1932x1910, 45° field of view, color fundus image
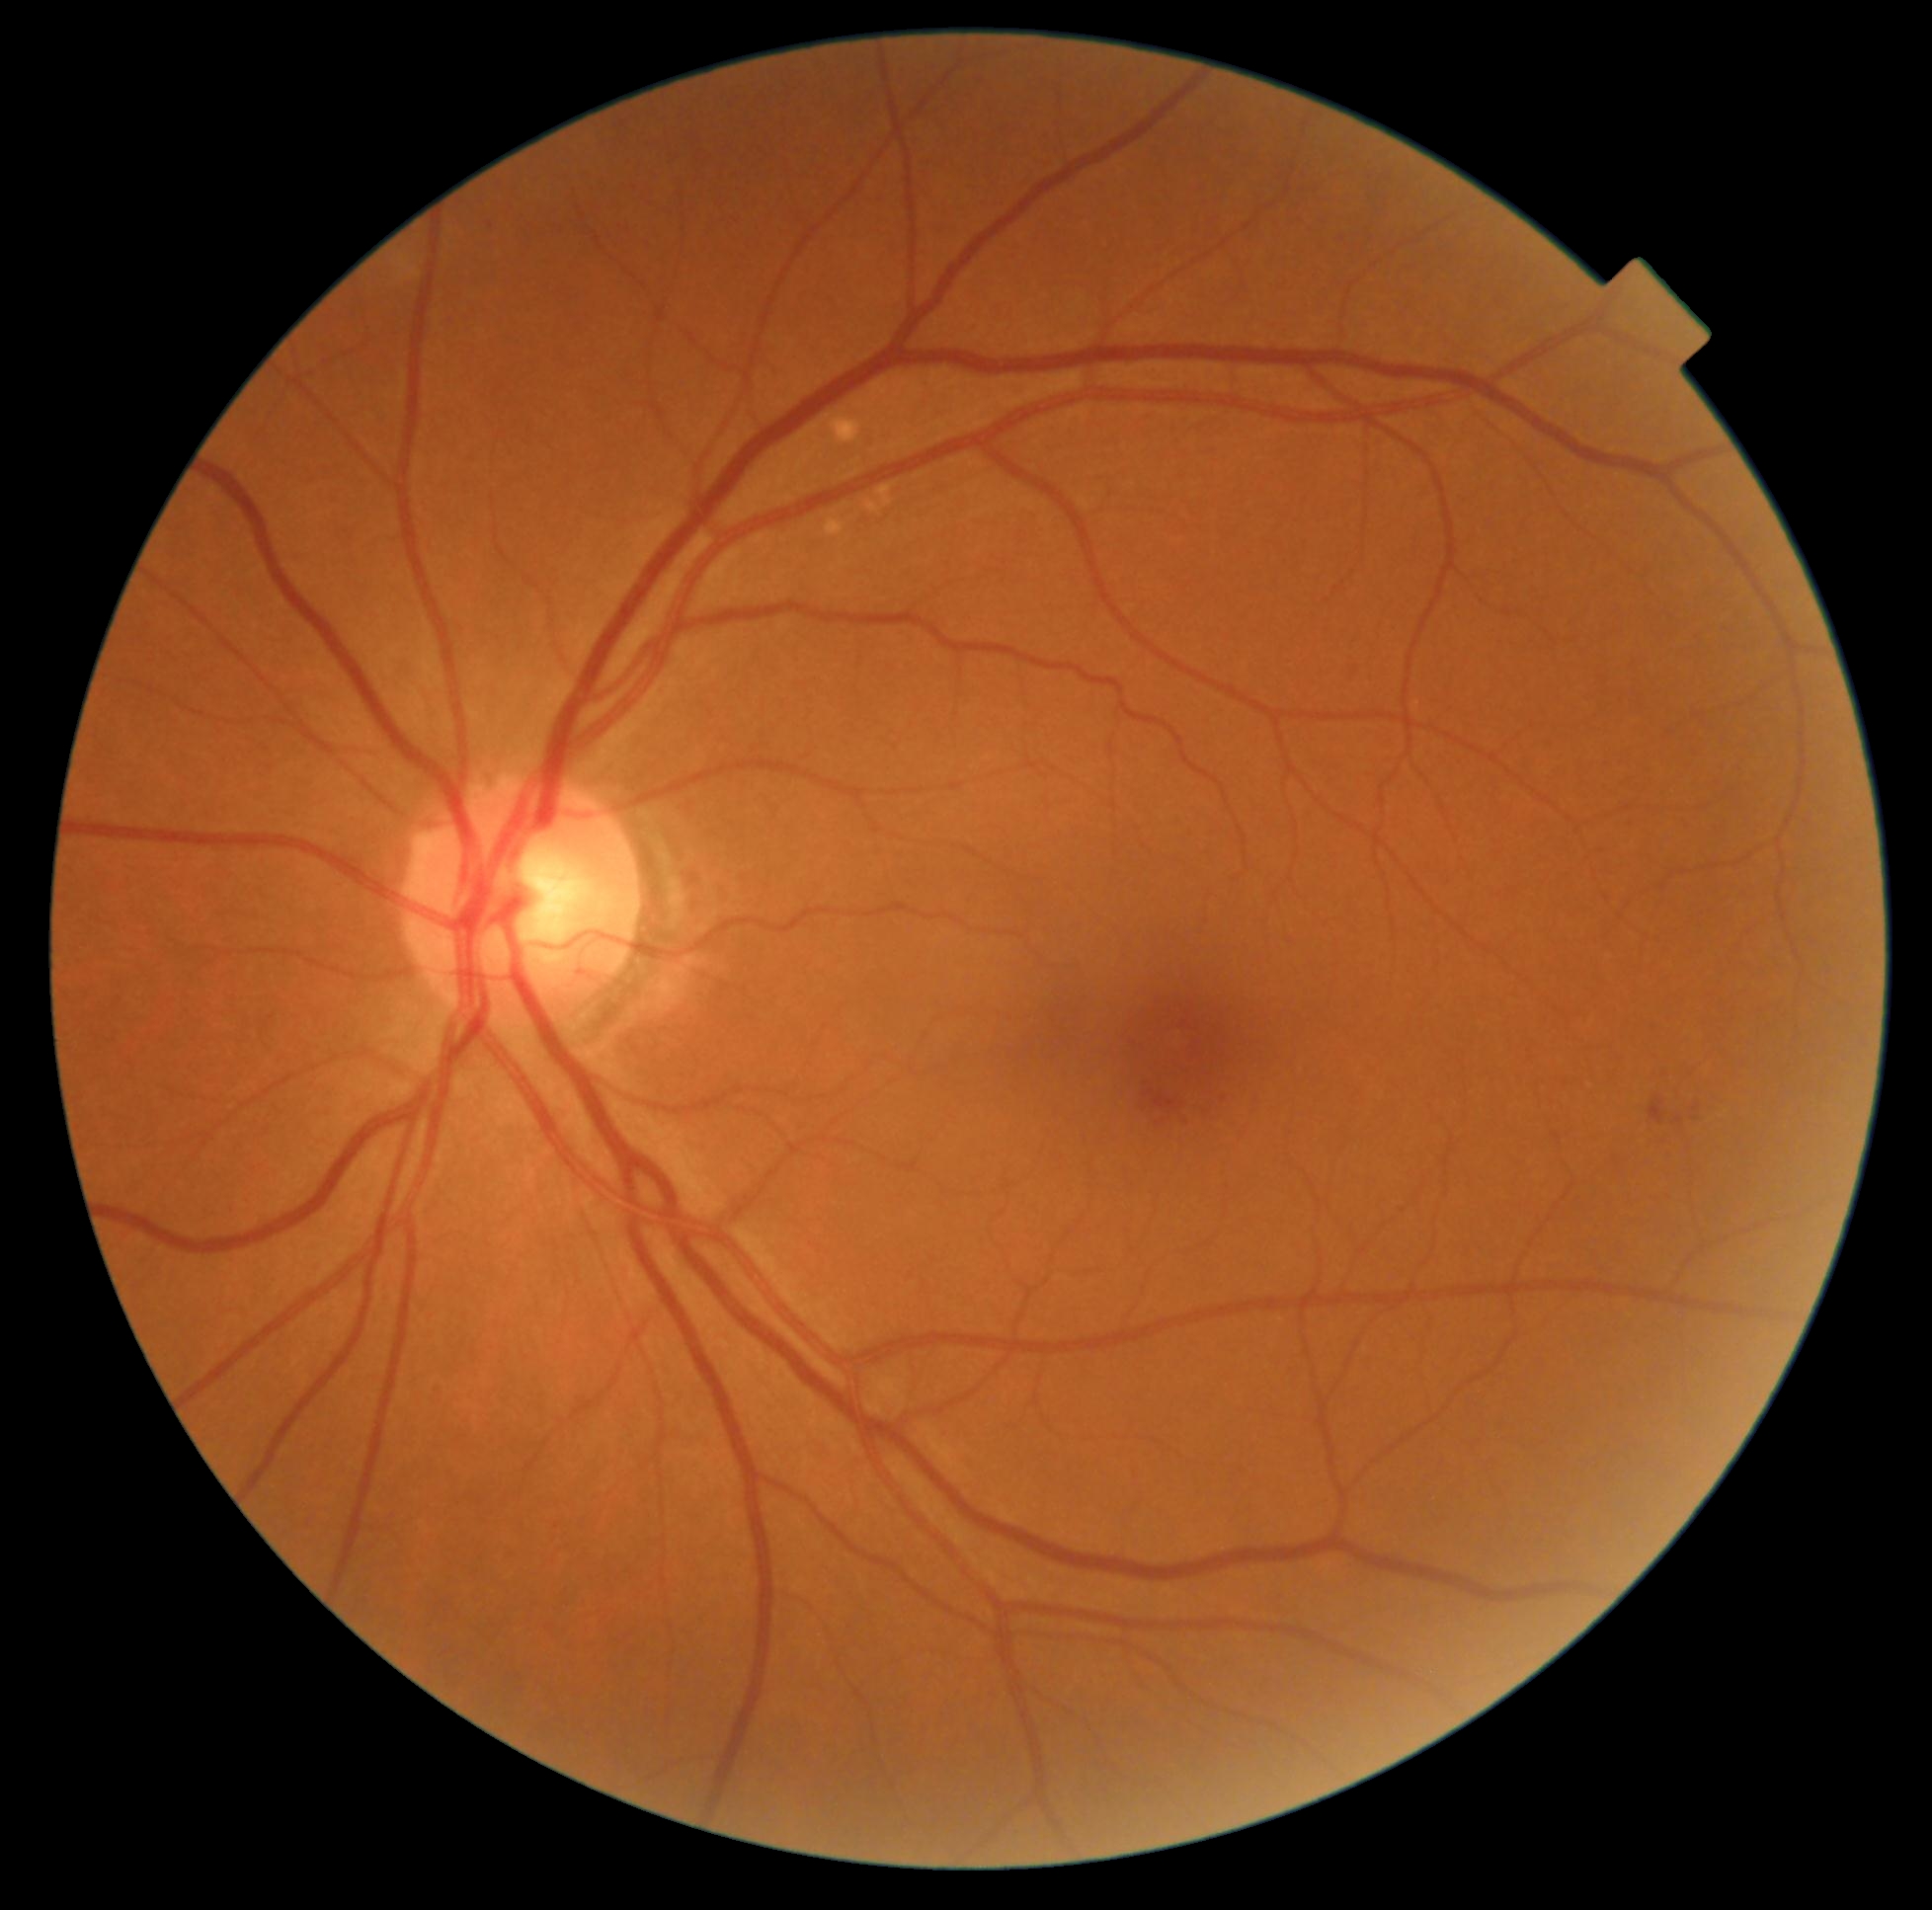

The retinopathy is classified as non-proliferative diabetic retinopathy.
DR grade: moderate non-proliferative diabetic retinopathy (2).